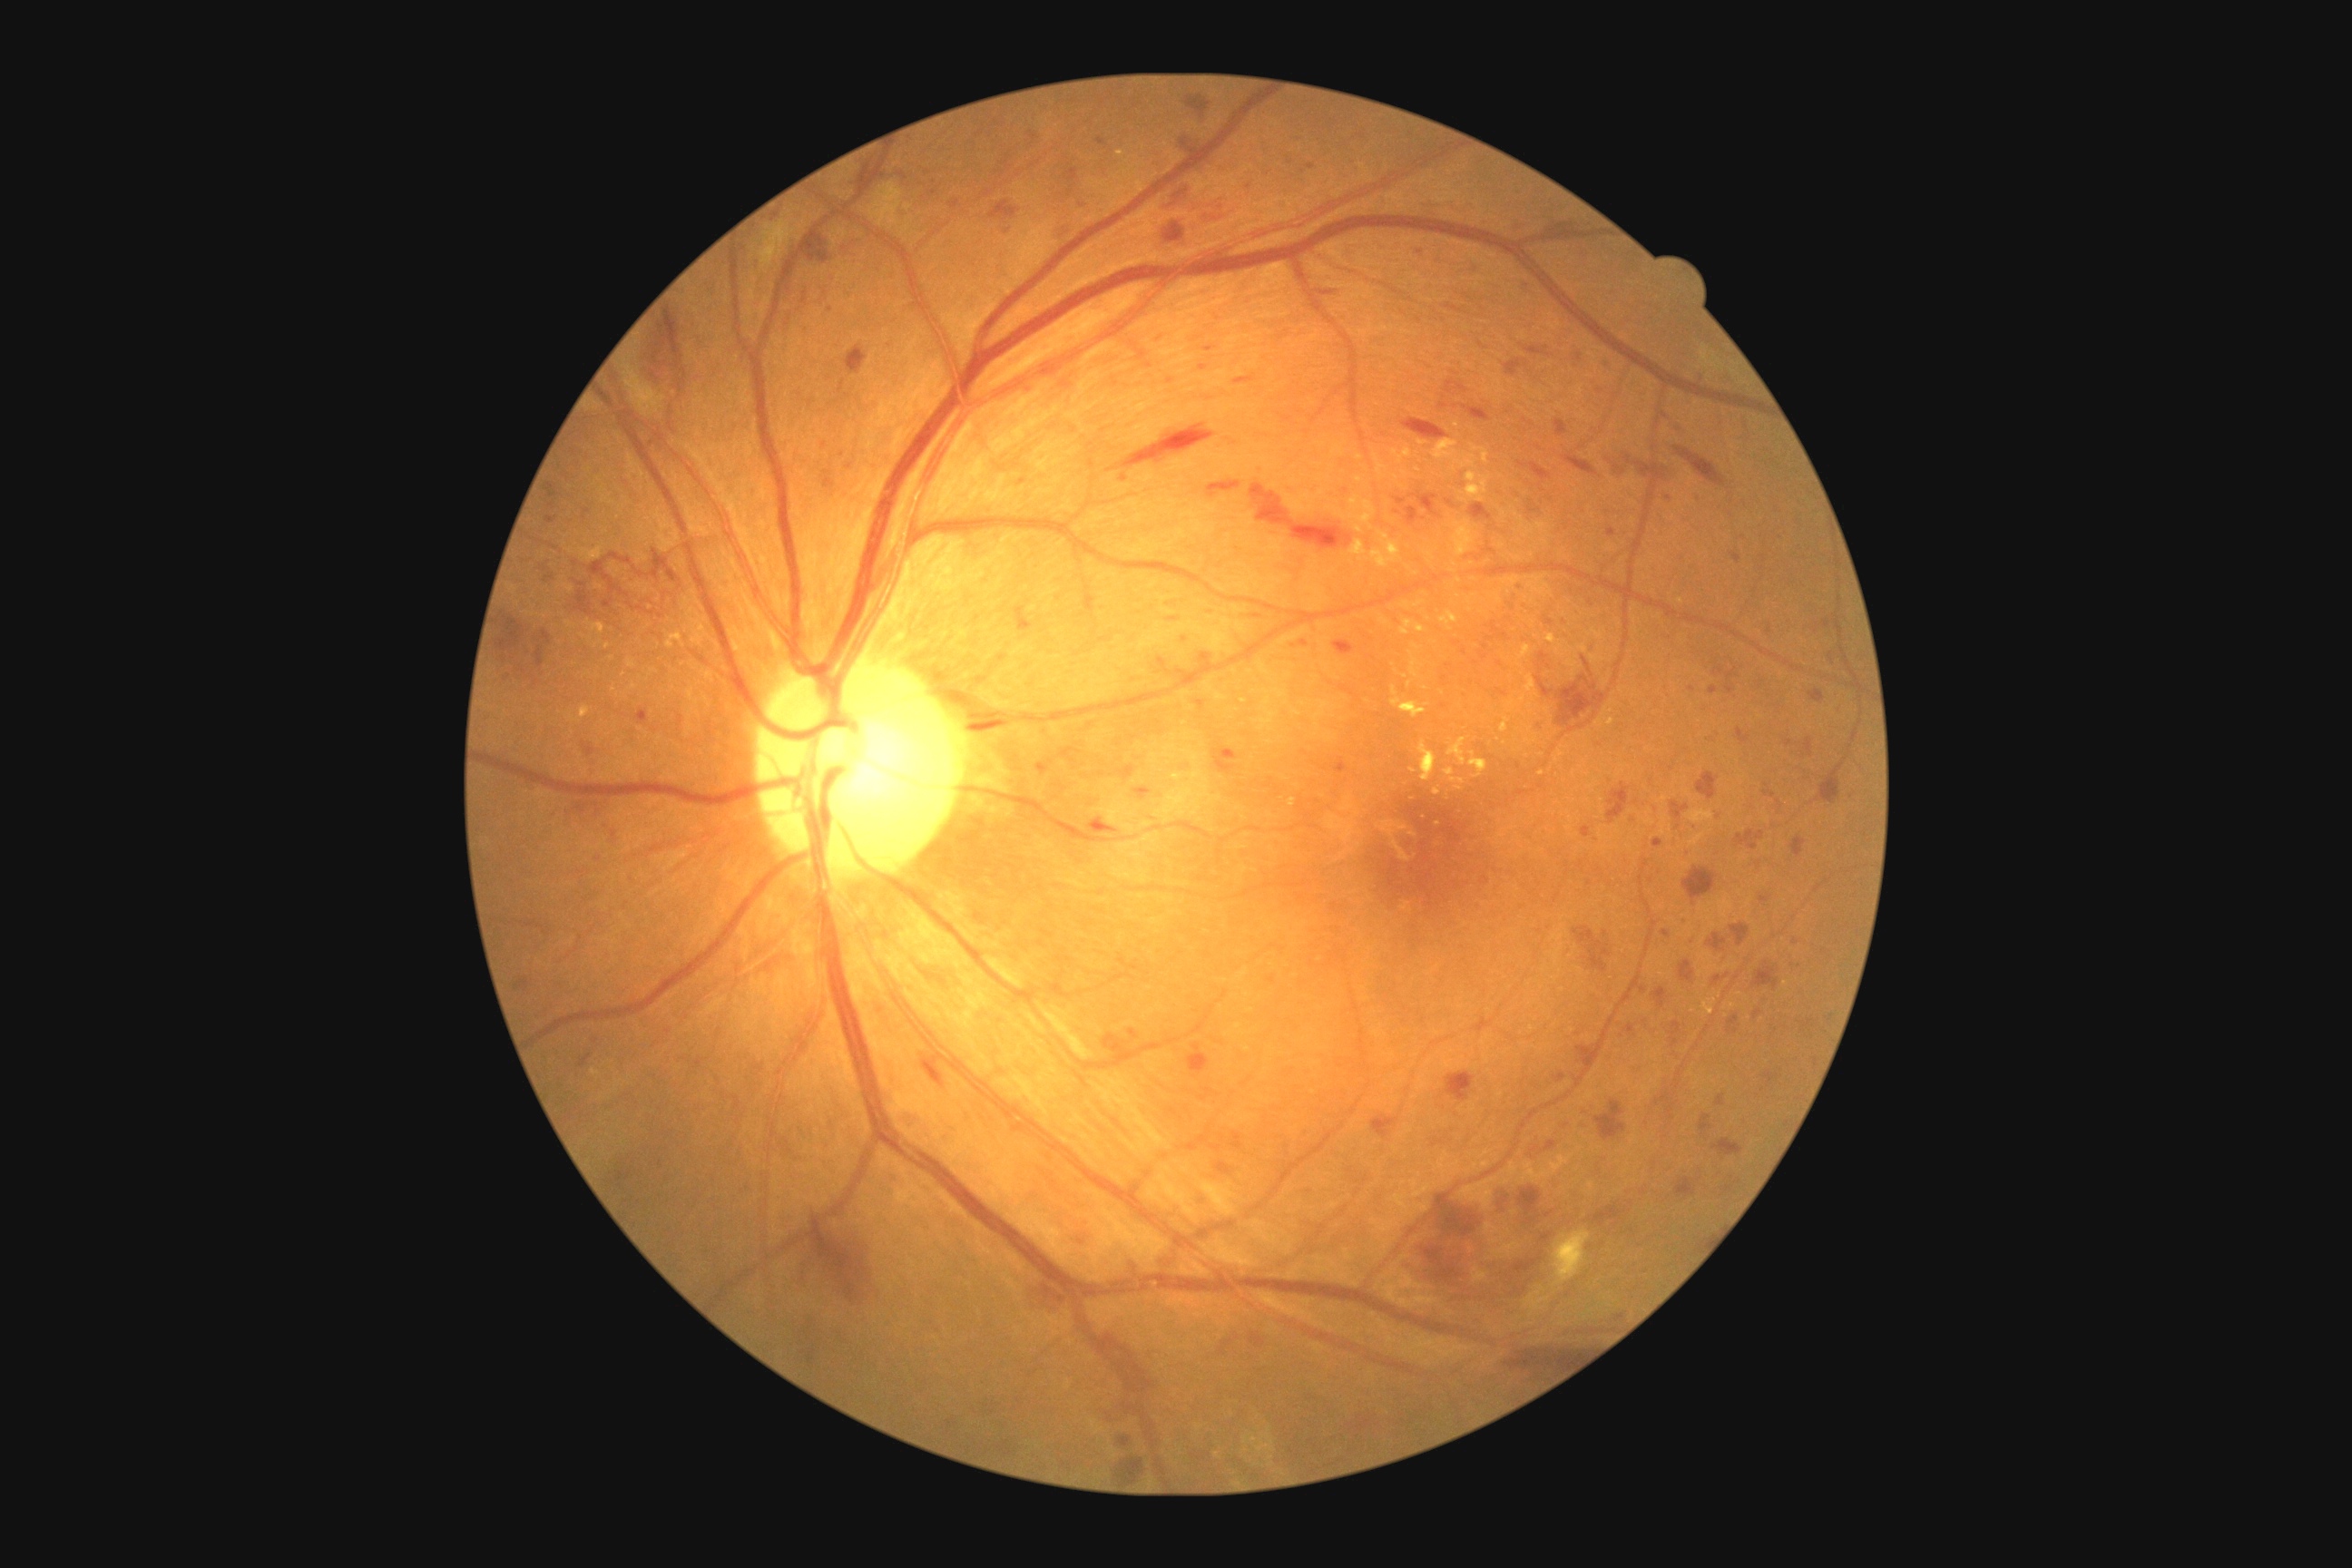

DR stage: grade 3 (severe NPDR)
A subset of detected lesions:
MAs (subset) = <region>1128, 1028, 1139, 1039</region> | <region>640, 716, 649, 721</region> | <region>1607, 529, 1616, 538</region> | <region>1037, 765, 1044, 774</region> | <region>1661, 930, 1672, 939</region> | <region>1583, 1122, 1589, 1130</region> | <region>547, 516, 558, 525</region> | <region>1750, 843, 1761, 848</region>
Smaller MAs around x=1311 y=167 | x=1158 y=335 | x=1566 y=1126 | x=1579 y=358 | x=927 y=173 | x=831 y=310 | x=1788 y=744 | x=1796 y=942
HEs (subset) = <region>1763, 1072, 1779, 1086</region> | <region>1473, 262, 1478, 273</region> | <region>1117, 765, 1135, 781</region> | <region>990, 202, 1019, 222</region> | <region>1217, 1162, 1231, 1175</region> | <region>1411, 1200, 1487, 1286</region> | <region>1440, 404, 1449, 409</region> | <region>1607, 783, 1631, 825</region> | <region>544, 574, 554, 585</region> | <region>1064, 168, 1079, 182</region> | <region>1618, 456, 1652, 478</region> | <region>1476, 1233, 1491, 1260</region> | <region>652, 308, 683, 369</region> | <region>1529, 505, 1540, 514</region> | <region>1117, 1458, 1144, 1482</region> | <region>1589, 640, 1596, 651</region> | <region>1469, 505, 1493, 520</region> | <region>1166, 186, 1195, 202</region> | <region>1538, 652, 1549, 665</region> | <region>1661, 469, 1680, 484</region>
EXs (subset) = <region>1418, 440, 1427, 447</region> | <region>1407, 798, 1415, 801</region> | <region>1547, 634, 1556, 645</region> | <region>1355, 478, 1364, 484</region> | <region>1289, 799, 1295, 807</region> | <region>1469, 752, 1487, 778</region> | <region>1409, 652, 1420, 678</region> | <region>1525, 674, 1540, 698</region> | <region>1418, 741, 1438, 783</region> | <region>1484, 449, 1491, 466</region> | <region>1446, 769, 1455, 778</region> | <region>1404, 447, 1415, 460</region> | <region>1500, 716, 1511, 734</region>
Smaller EXs around x=1733 y=1007 | x=1413 y=771 | x=1405 y=677 | x=615 y=689 | x=623 y=676 | x=1438 y=825